Pediatric retinal photograph (wide-field)
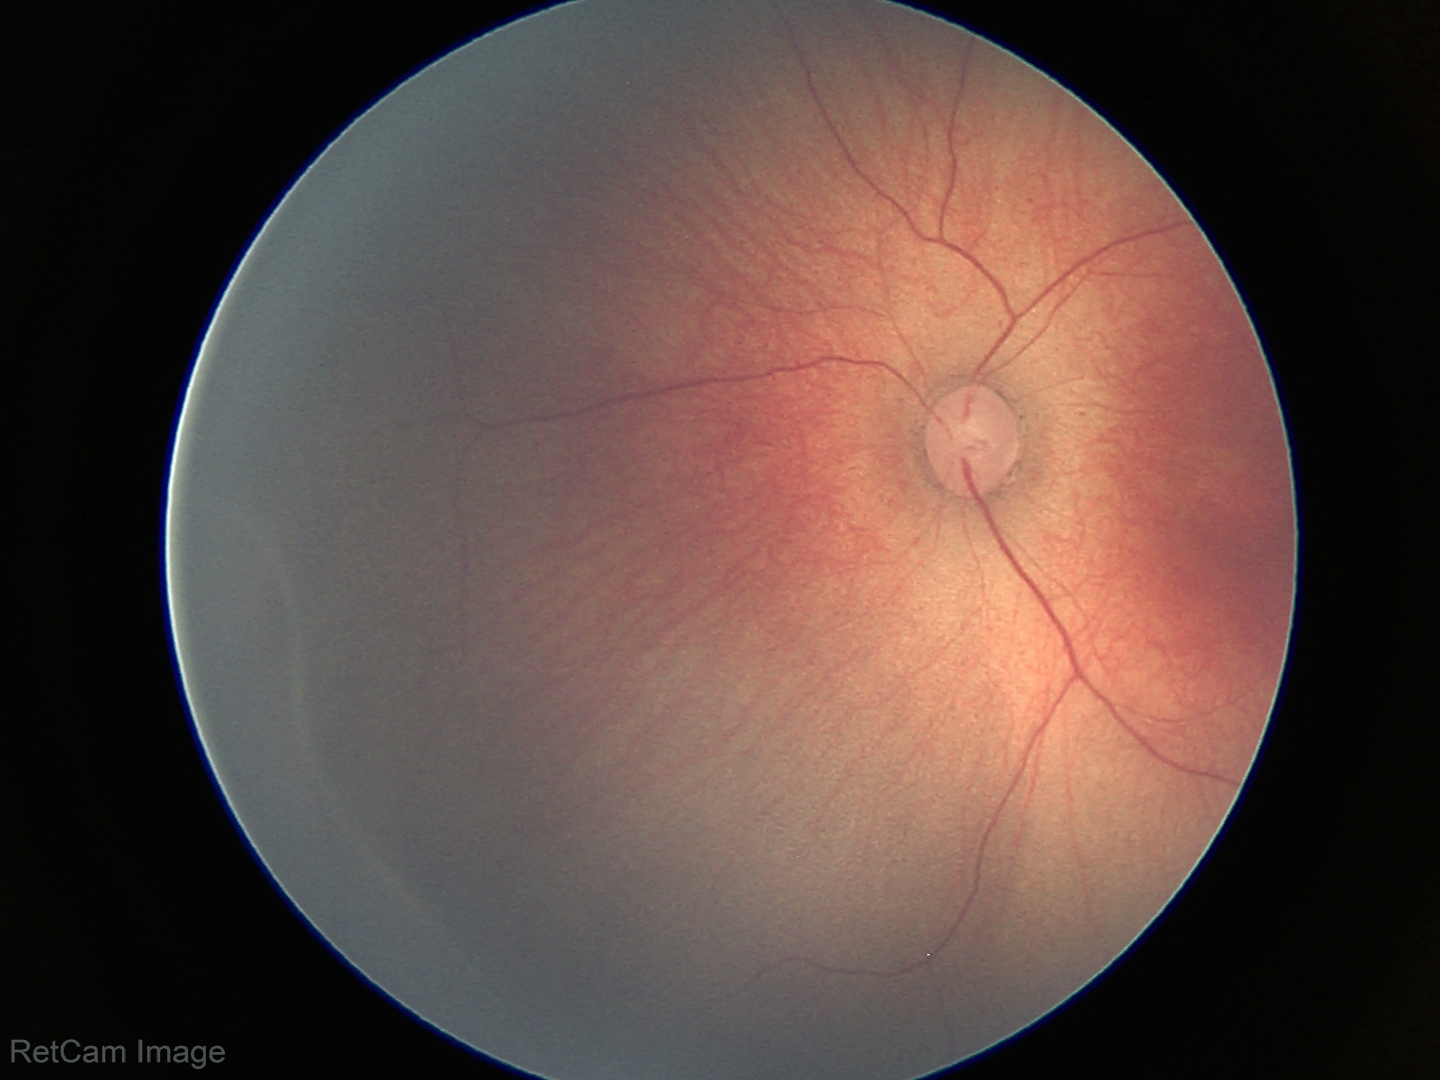 Series diagnosed as retinopathy of prematurity stage 2.